640x480px · wide-field fundus image from infant ROP screening:
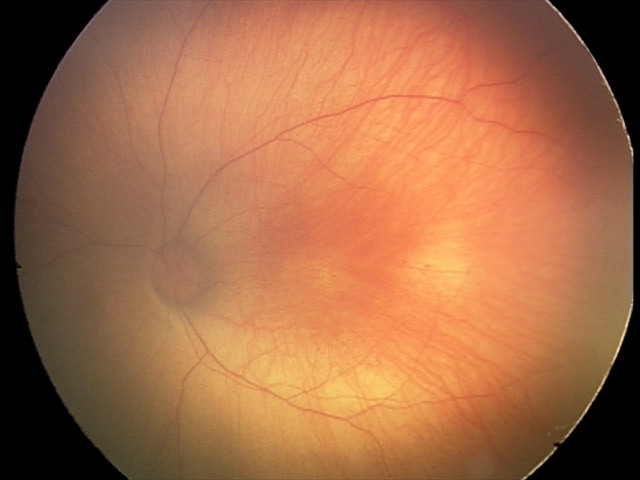
Impression = retinal hemorrhages.